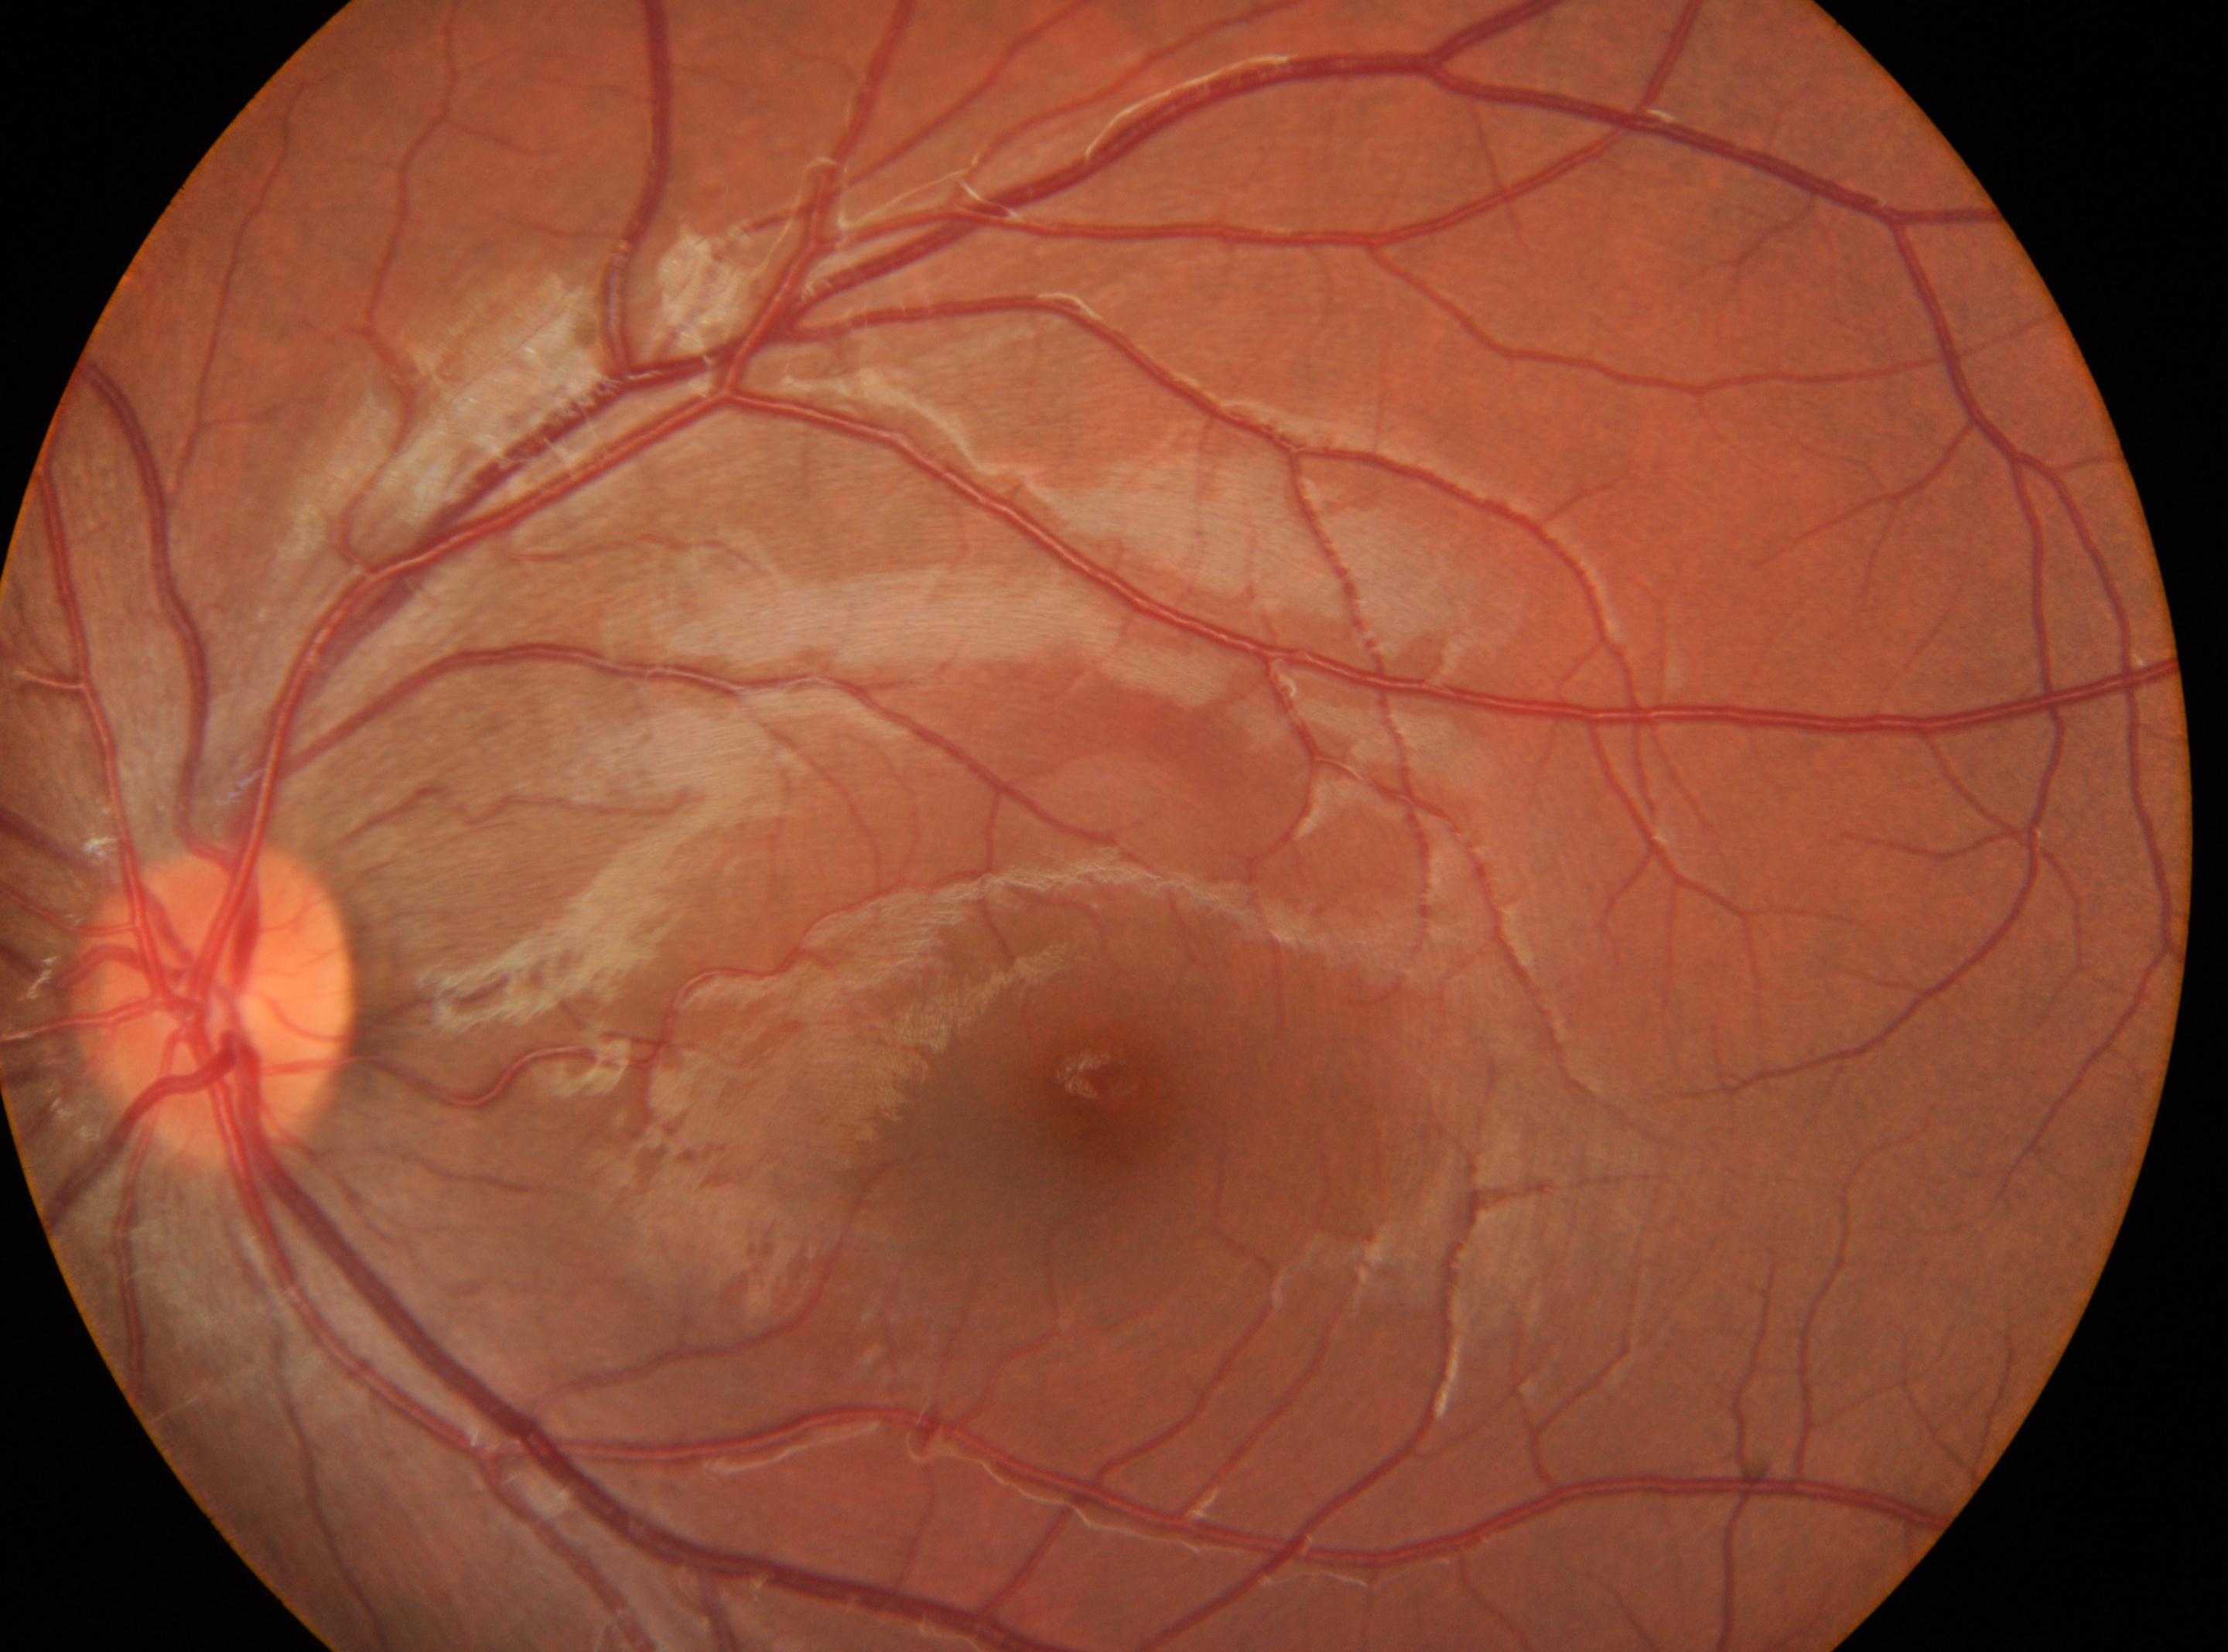

This is the oculus sinister. The macular center is at 1105, 1100. Optic disk located at 217, 1004. Diabetic retinopathy severity: no apparent diabetic retinopathy (grade 0).